Image size 1932x1932:
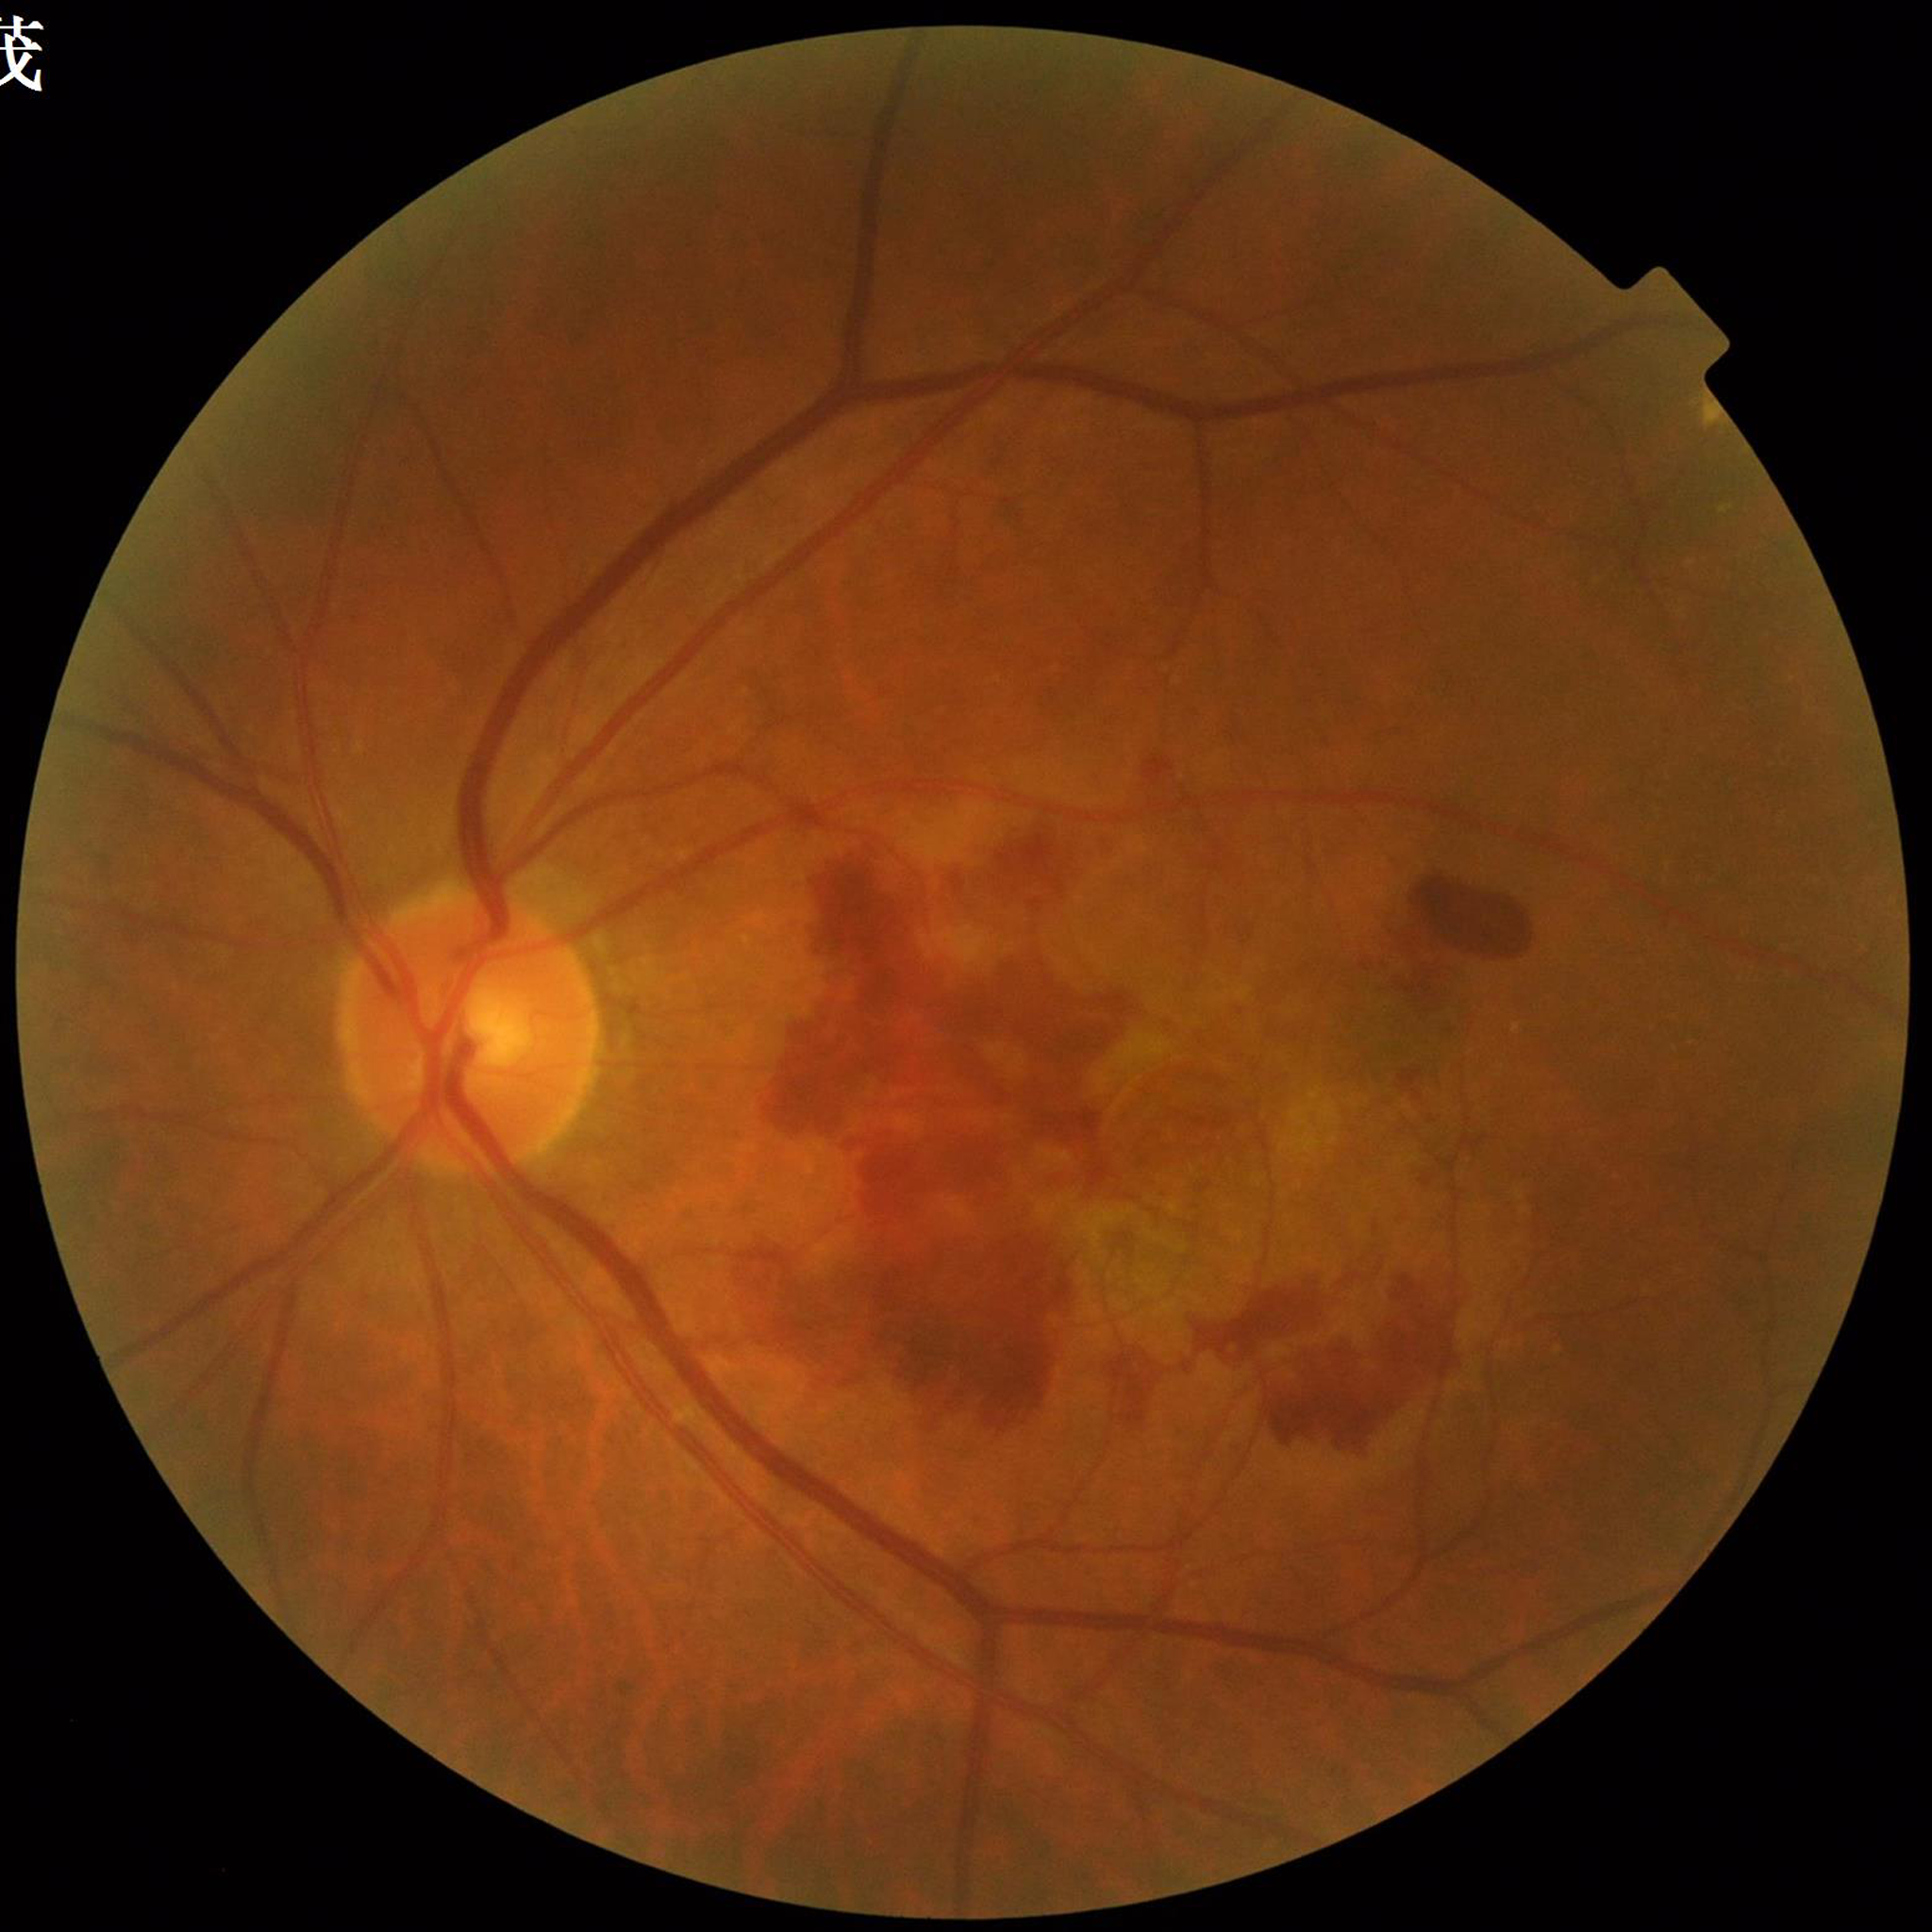

The patient was diagnosed with age-related macular degeneration.